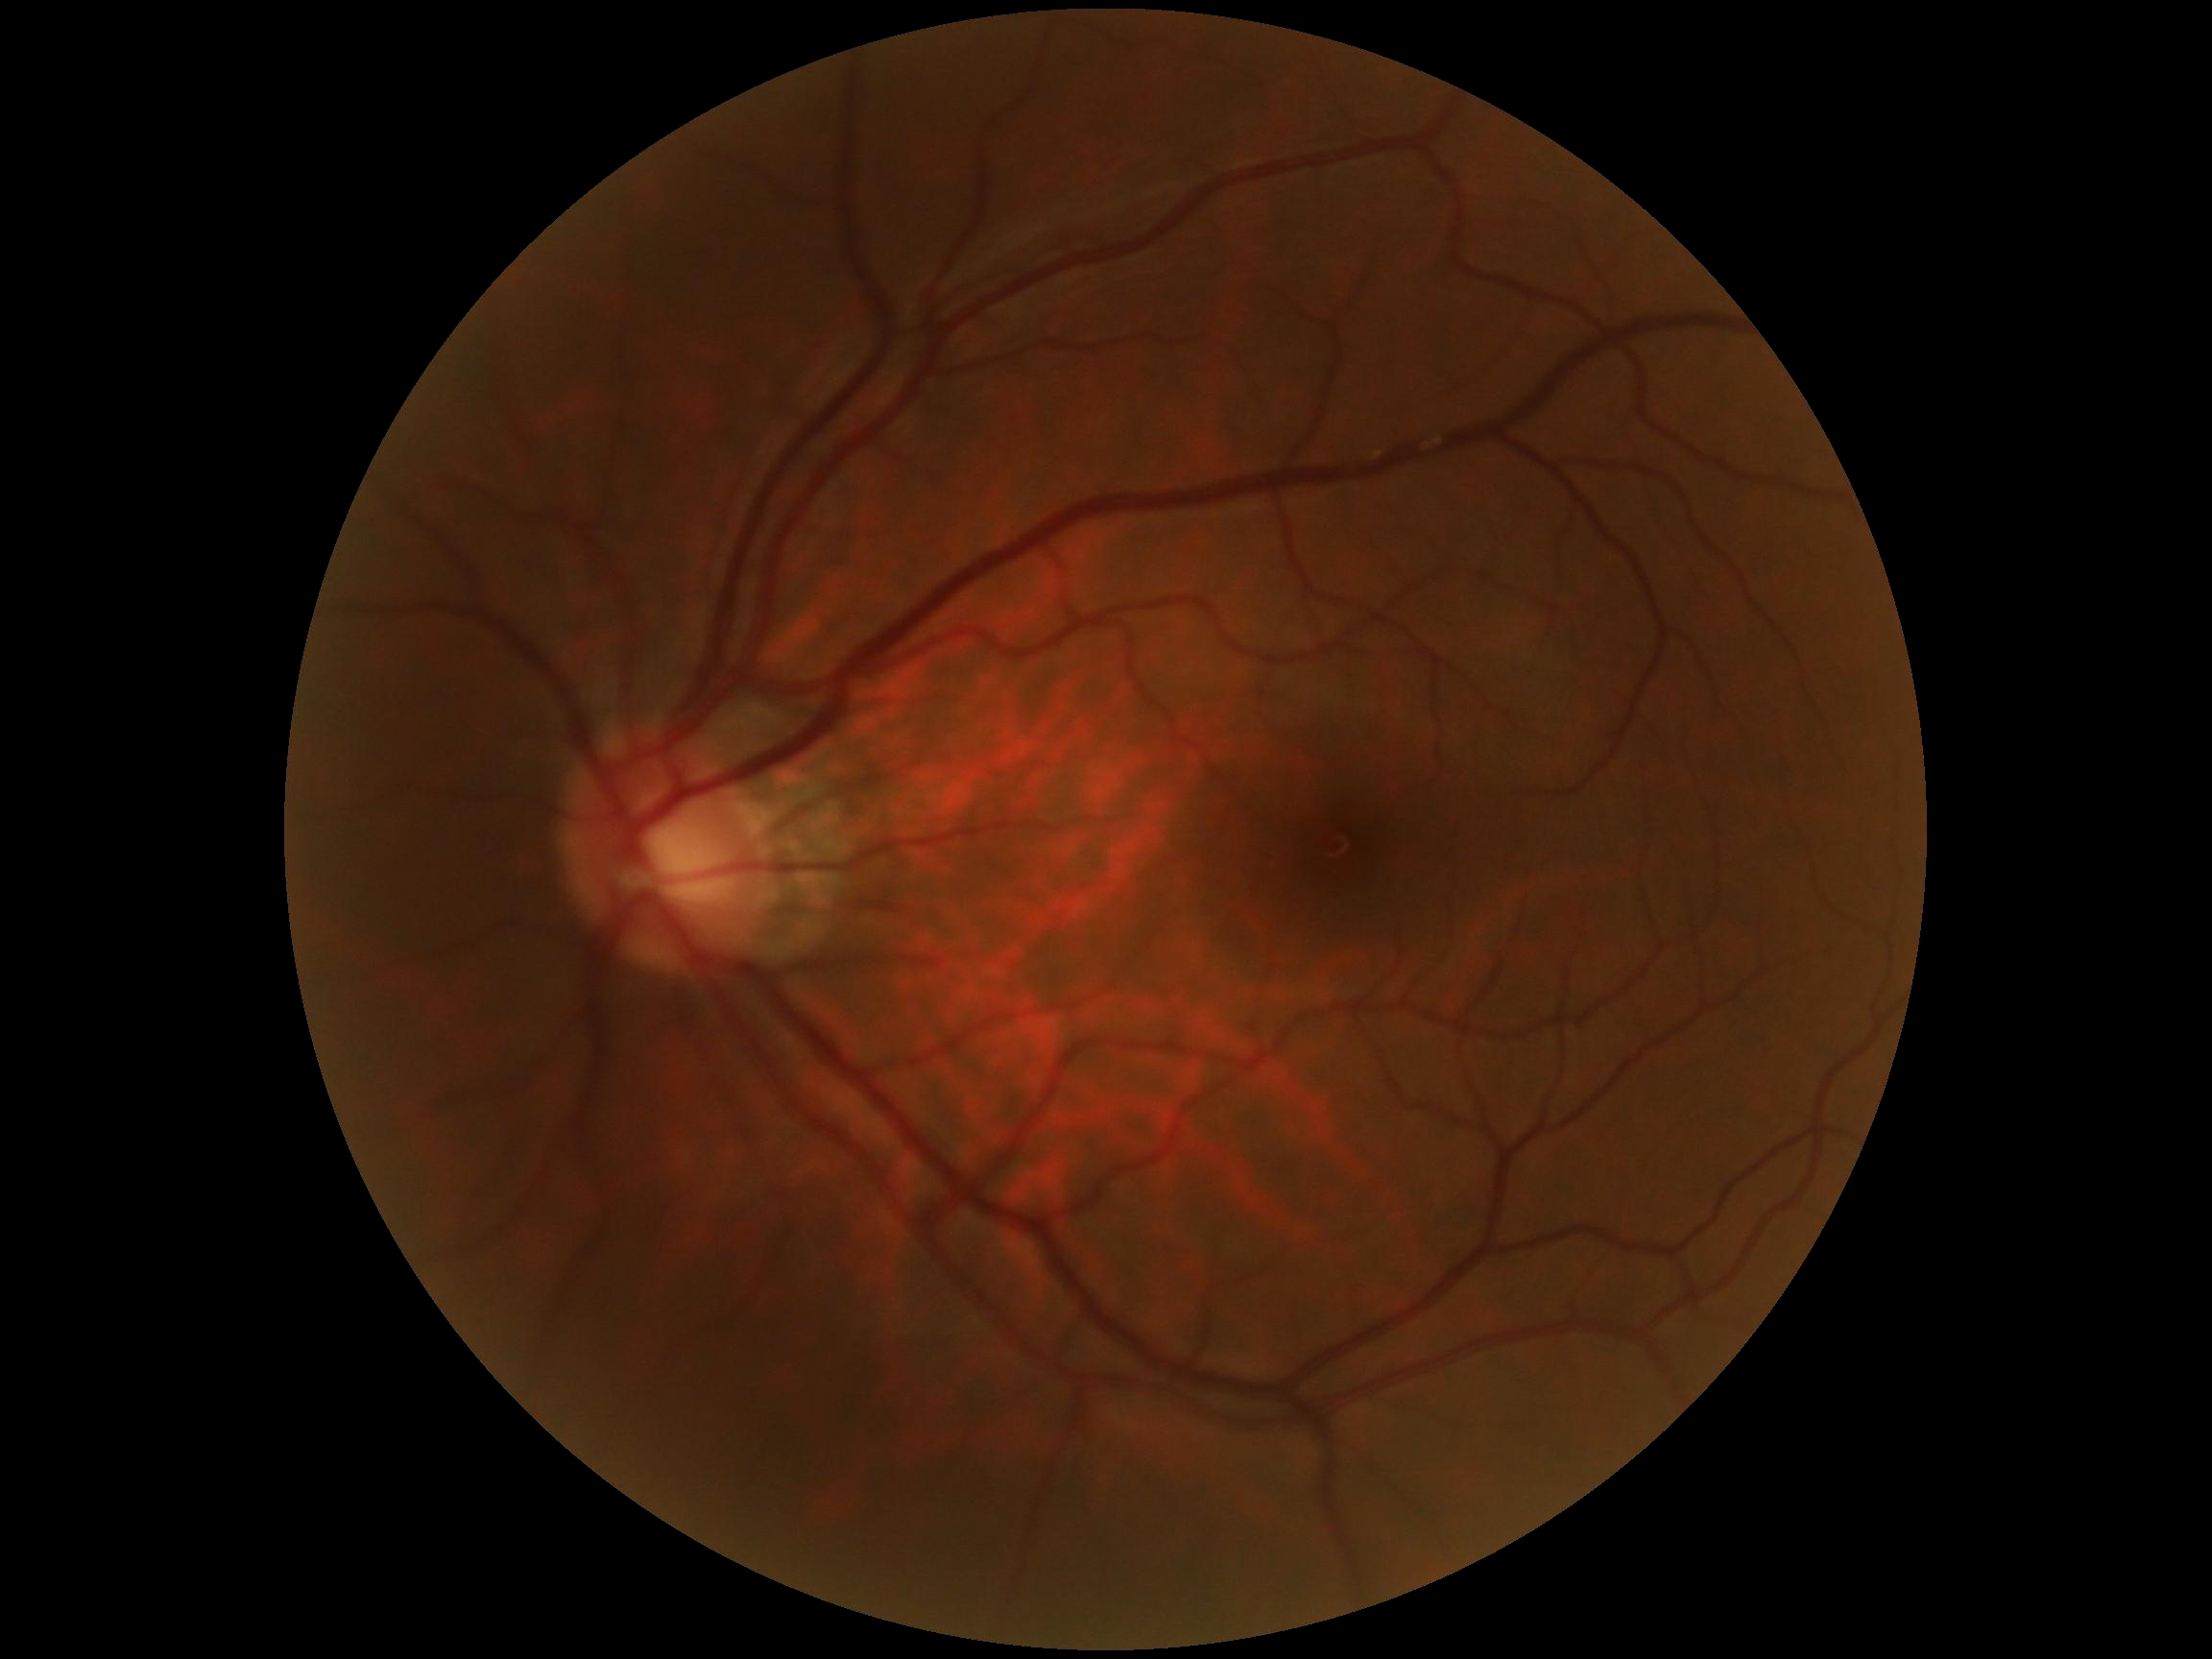 Diabetic retinopathy (DR): grade 0 (no apparent retinopathy) — no visible signs of diabetic retinopathy.